Retinal fundus photograph. Modified Davis grading. FOV: 45 degrees — 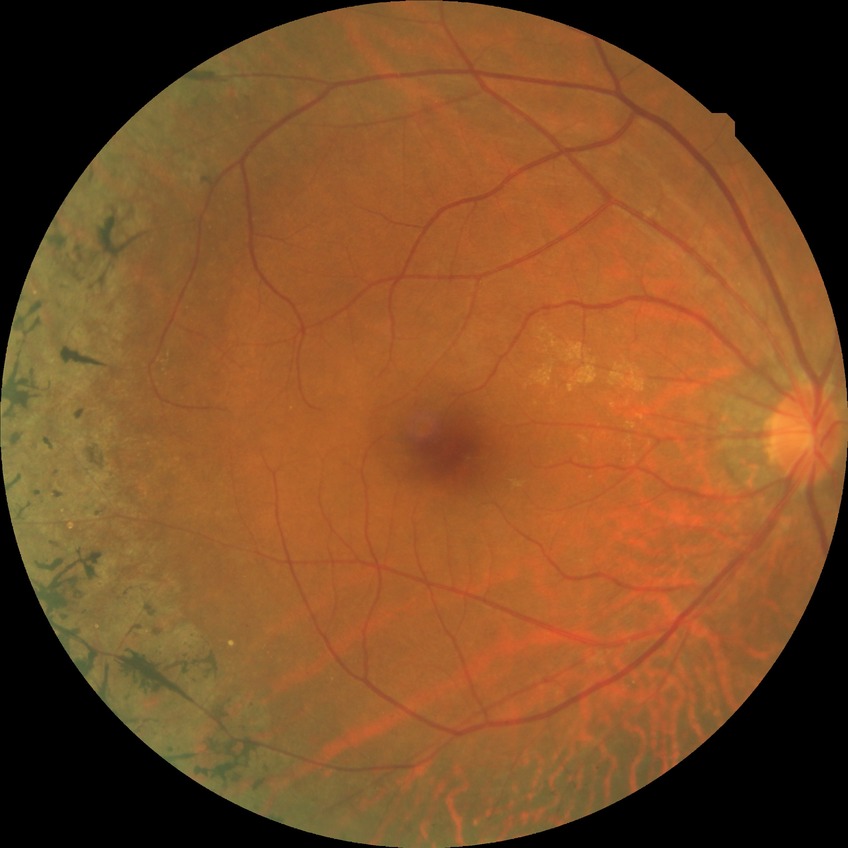

Diabetic retinopathy (DR): NDR (no diabetic retinopathy).